CFP · 45° FOV · 2048 x 1536 pixels: 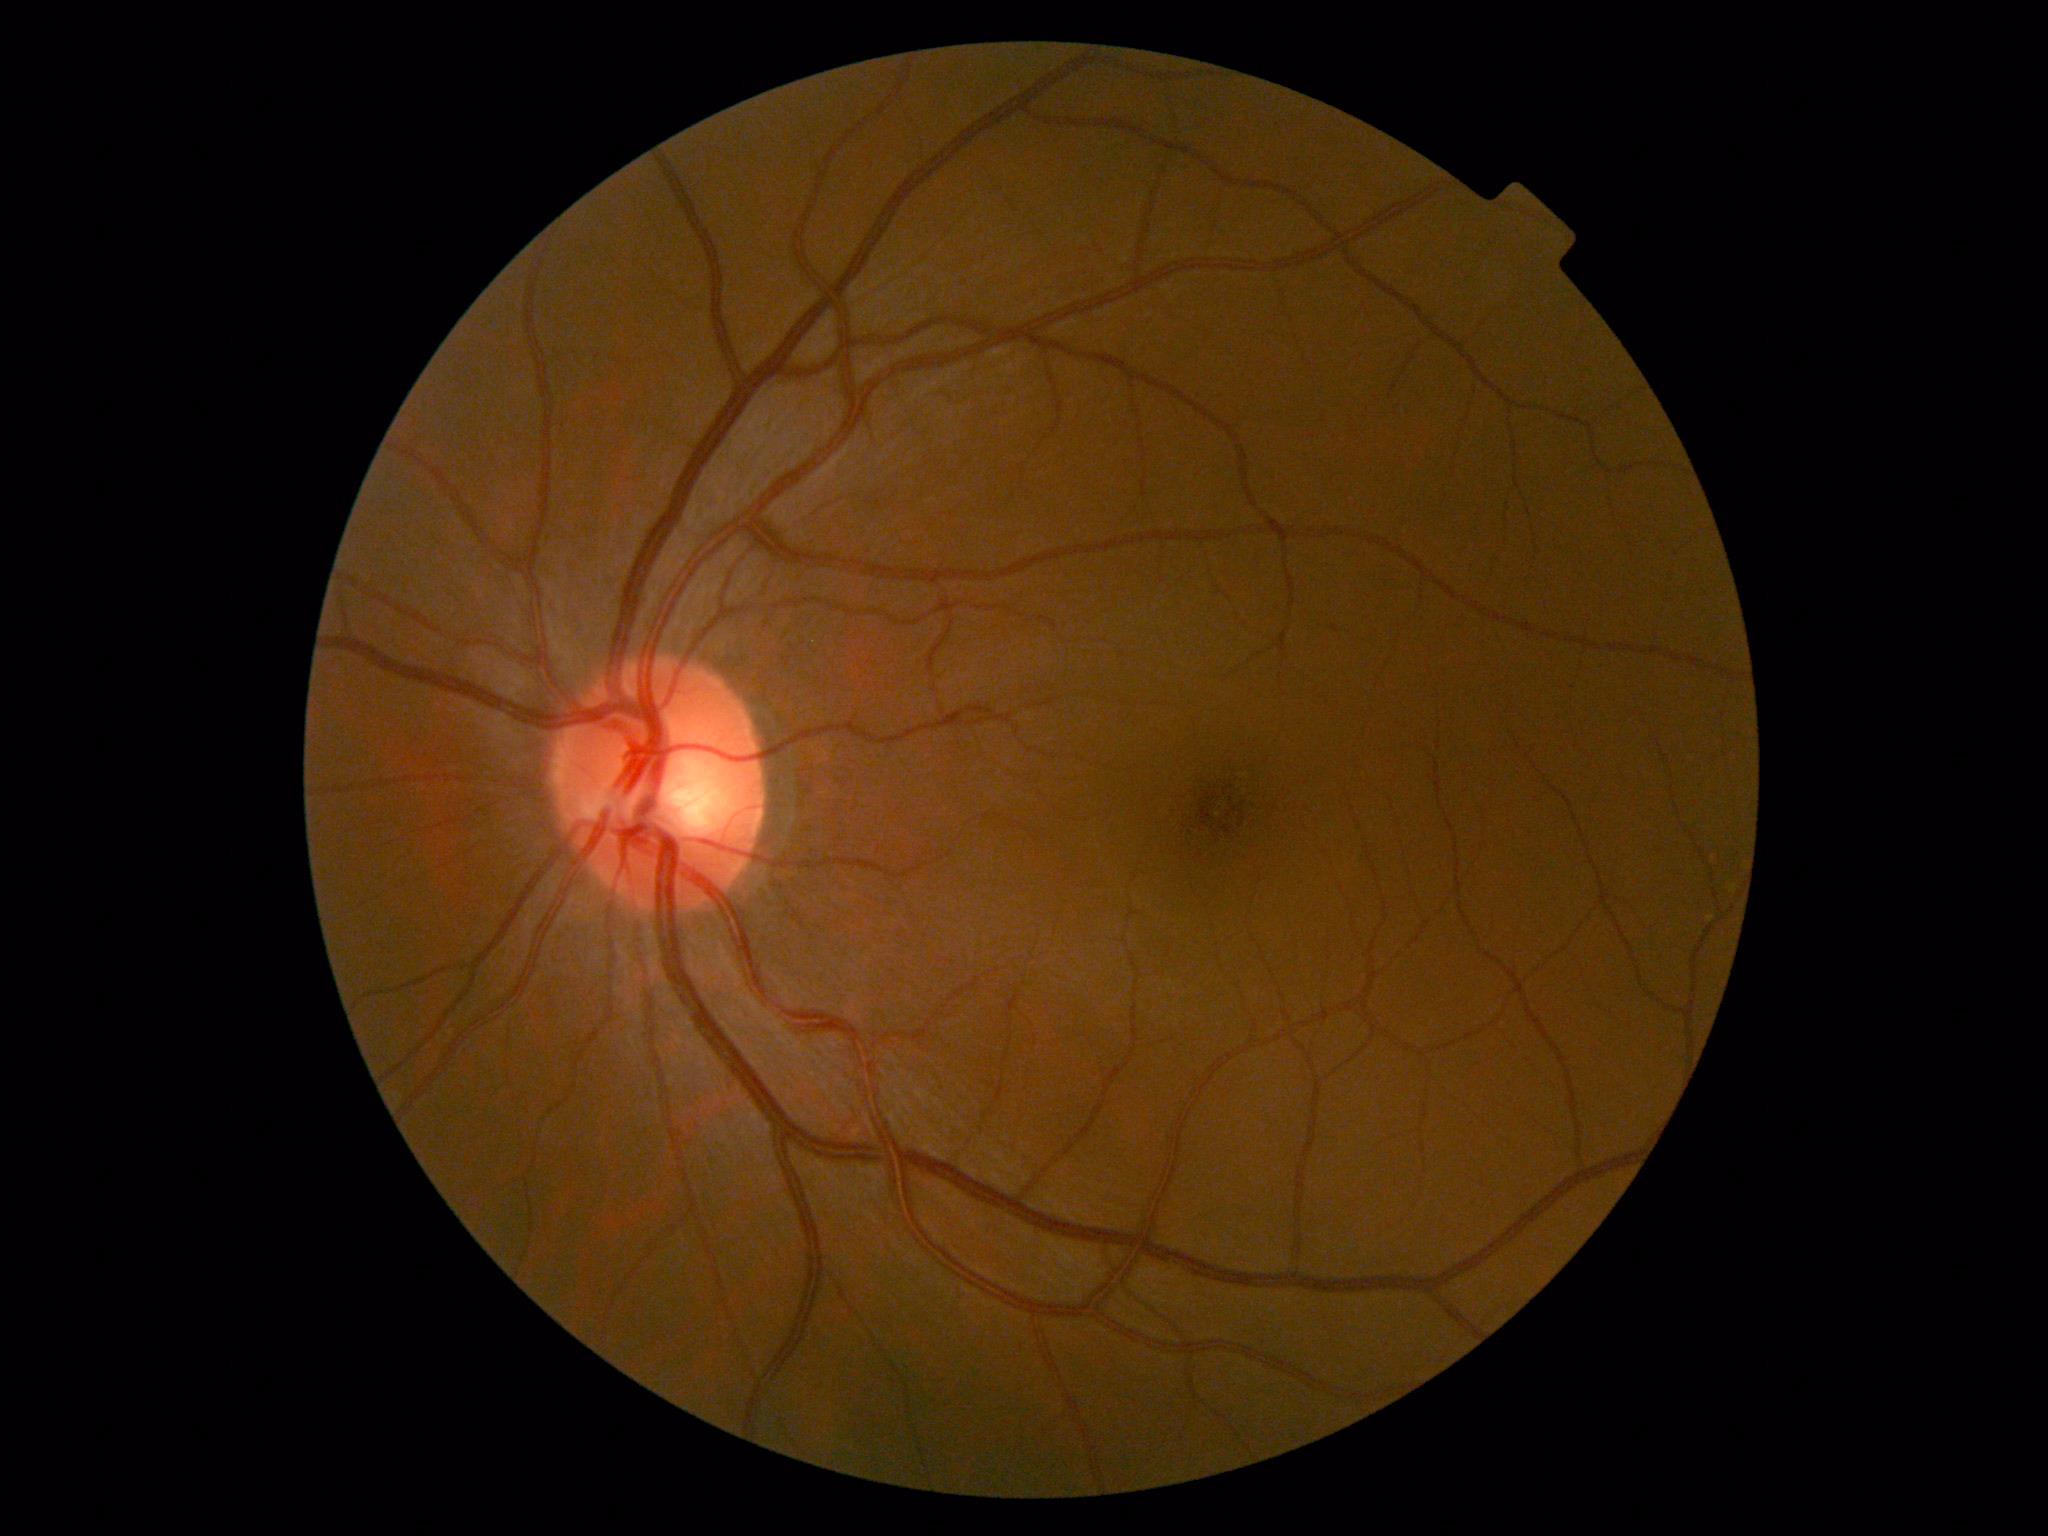 Diabetic retinopathy severity: grade 0 (no apparent retinopathy).